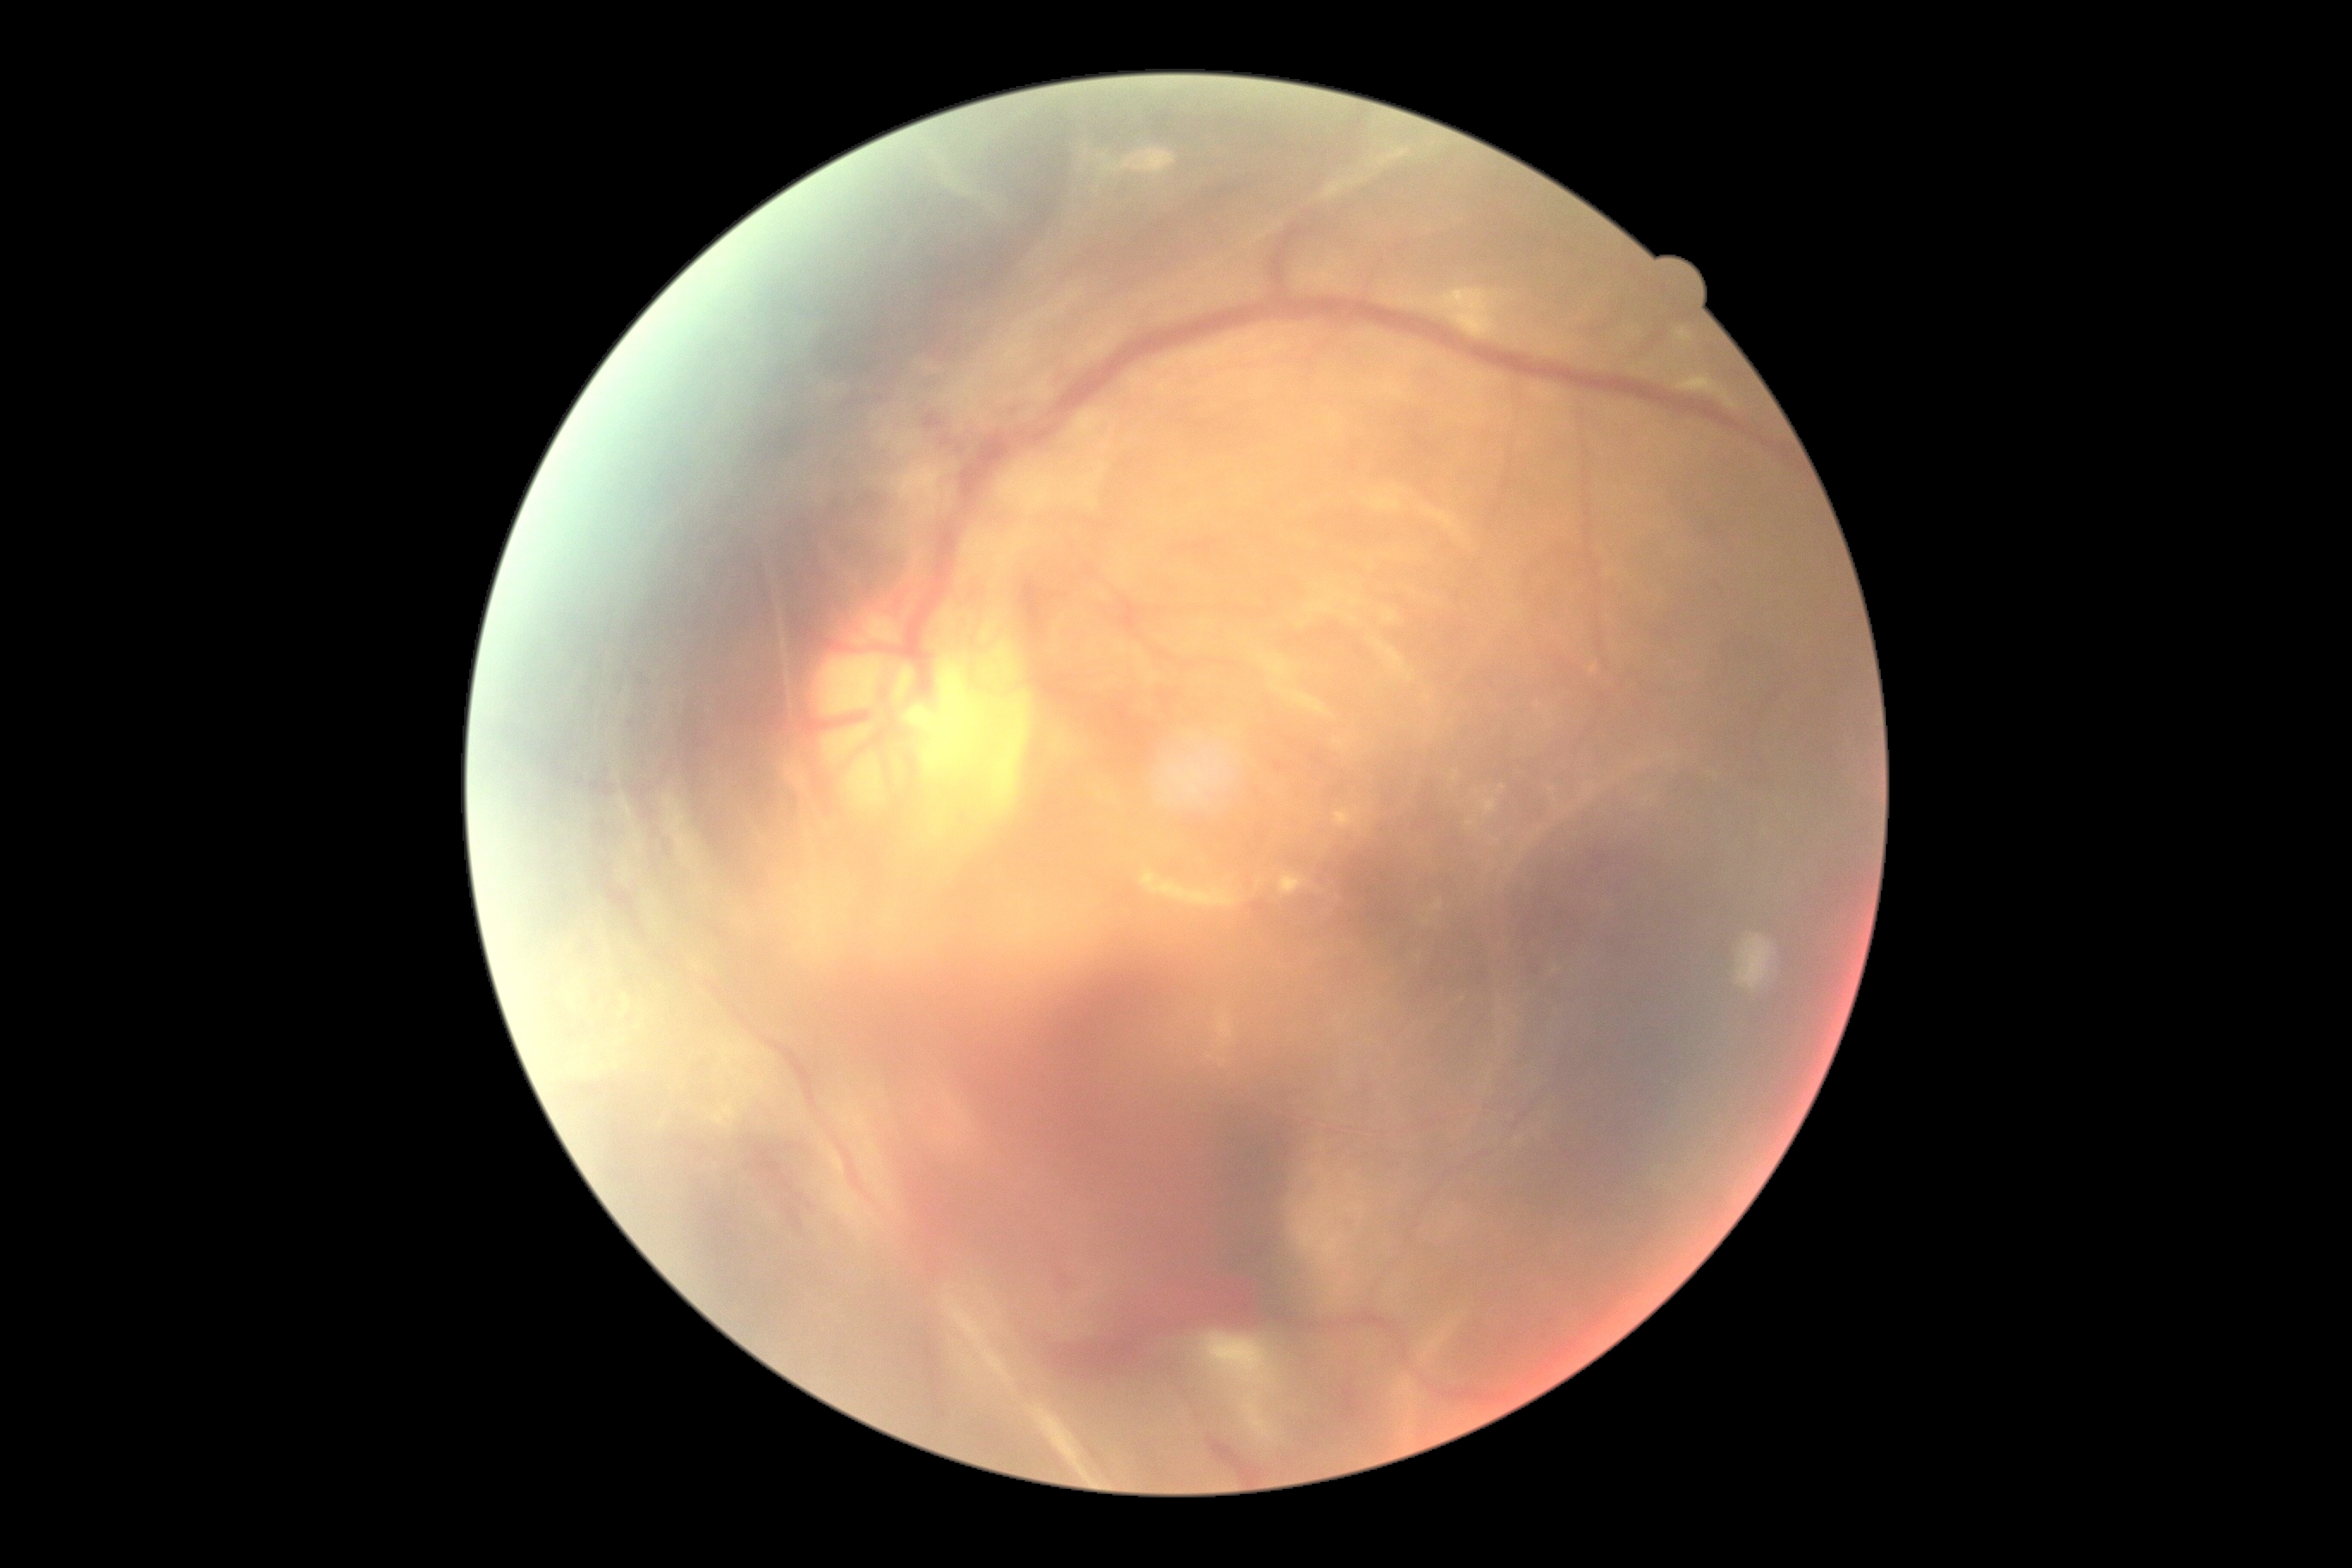
DR severity: 4